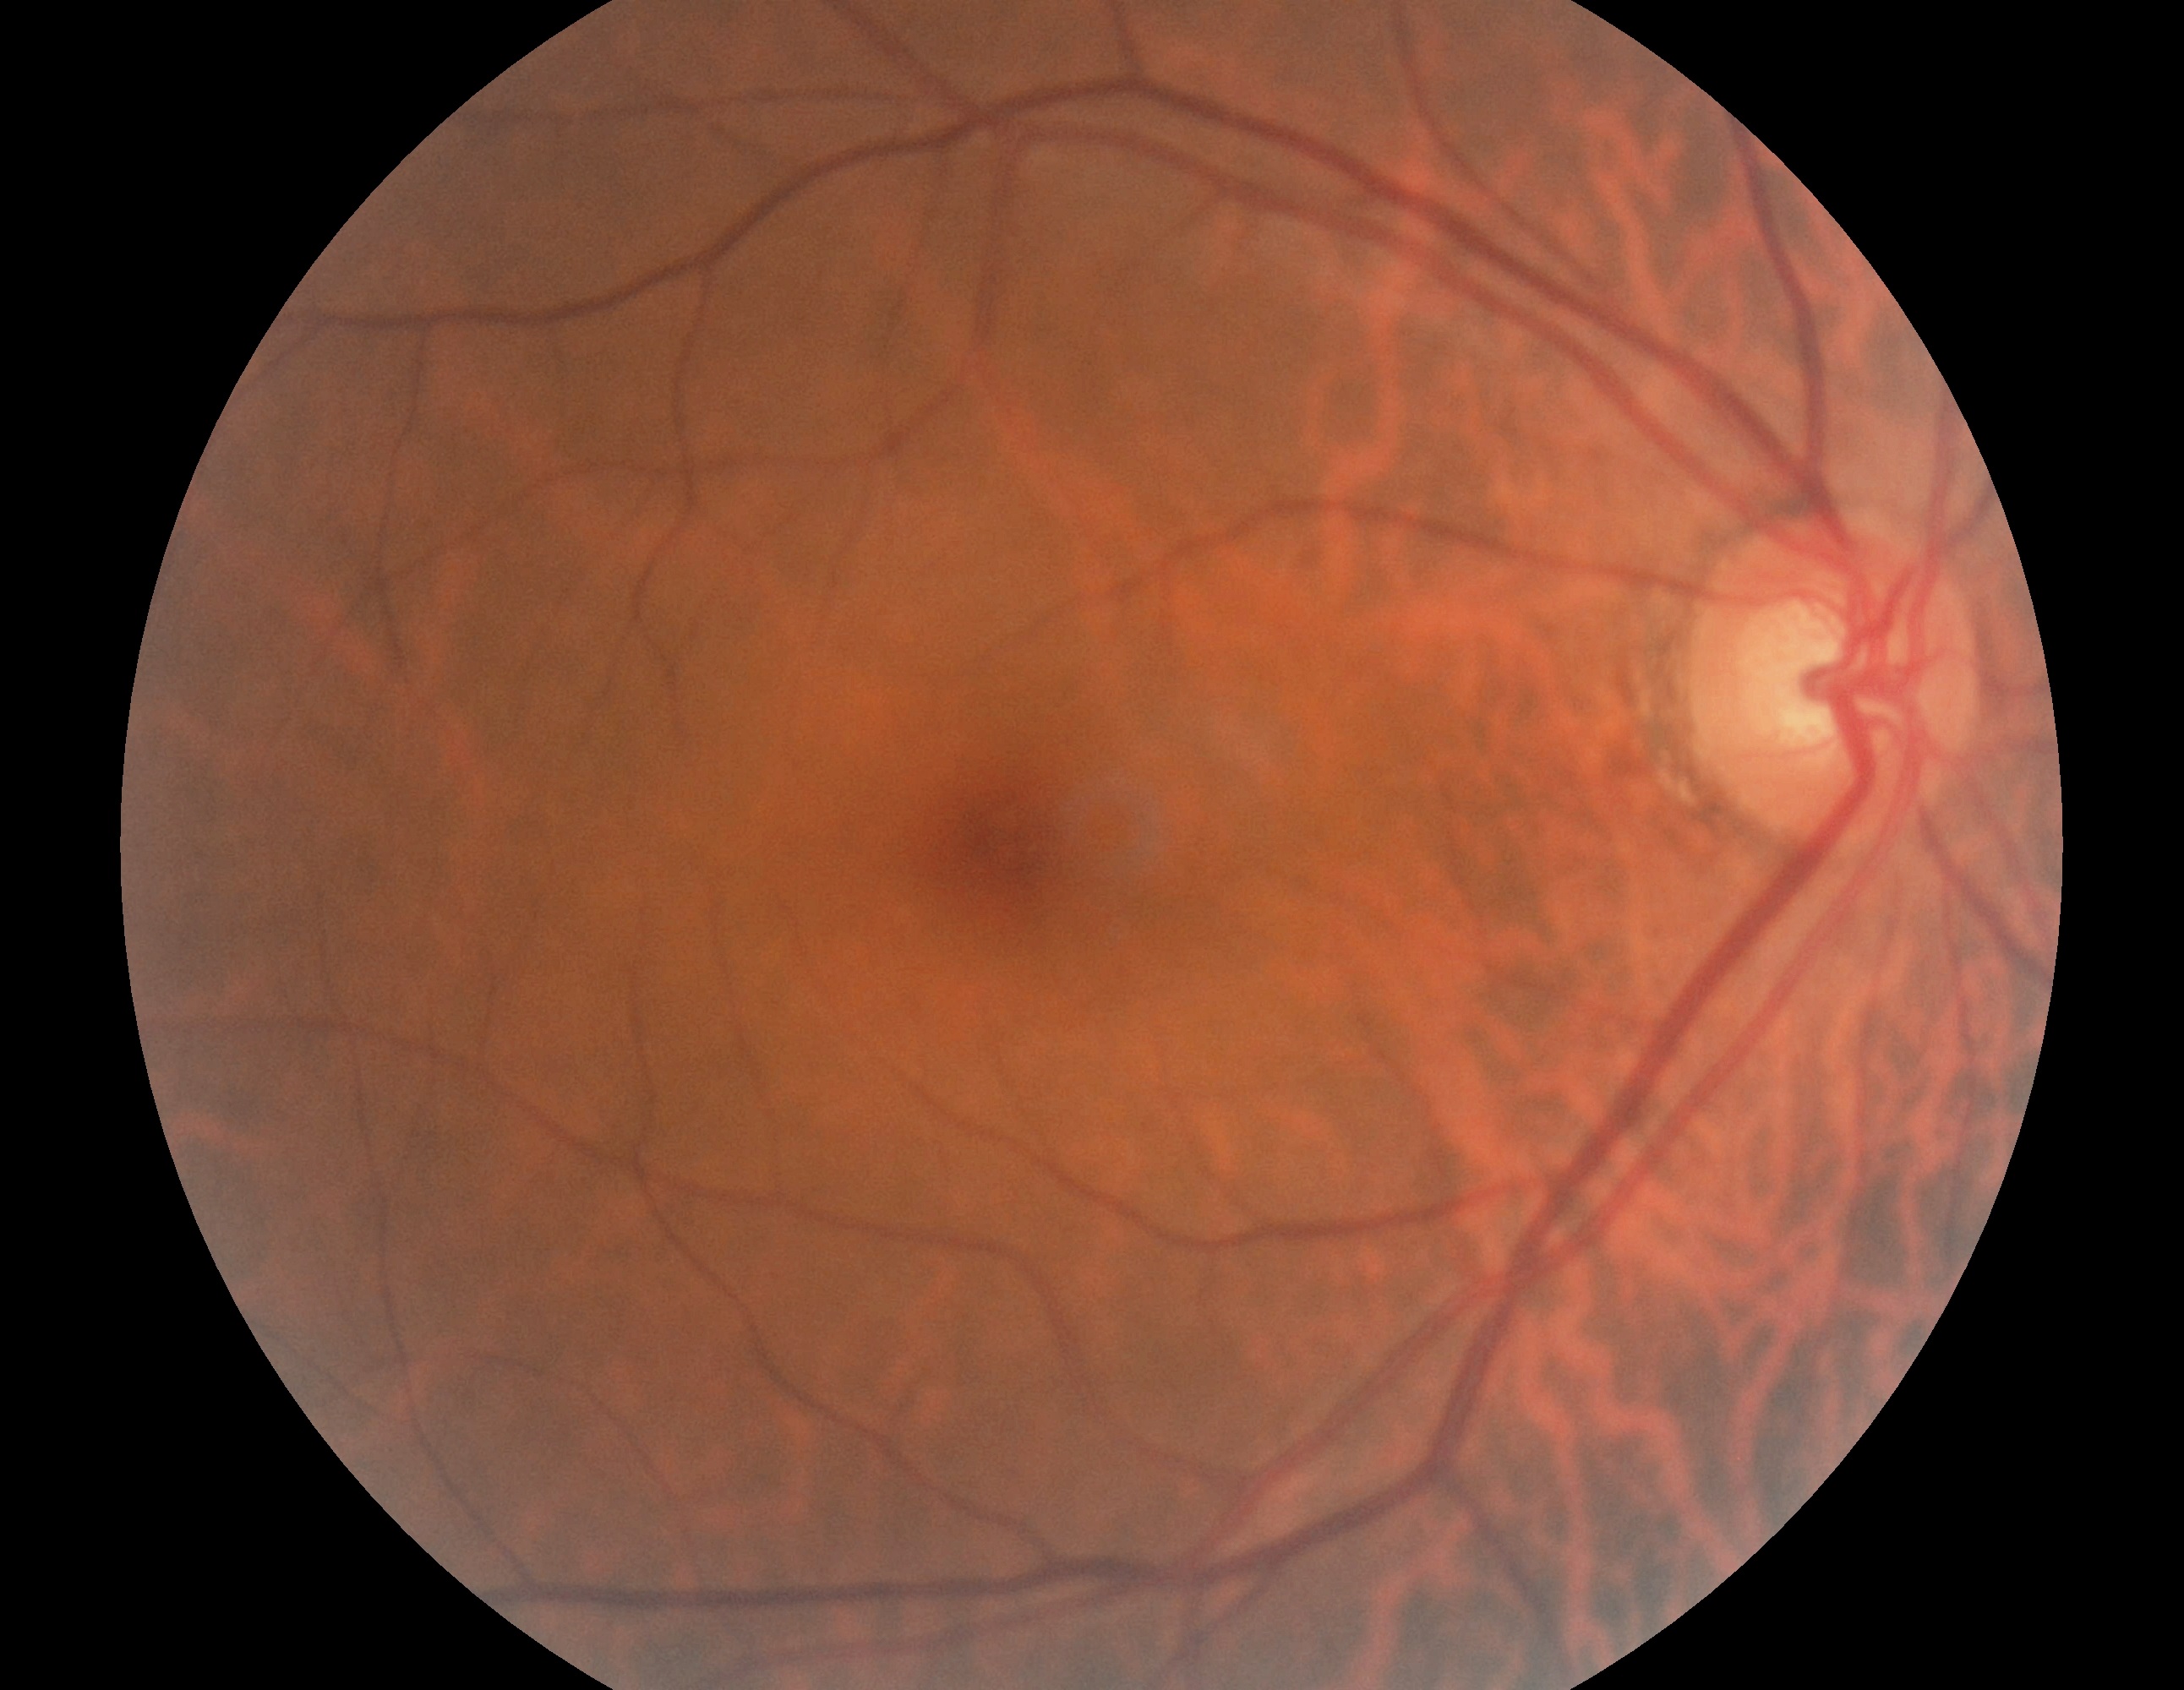 {
  "dr_grade": "no apparent retinopathy (grade 0)",
  "dr_impression": "no apparent DR"
}